1659 by 2212 pixels: 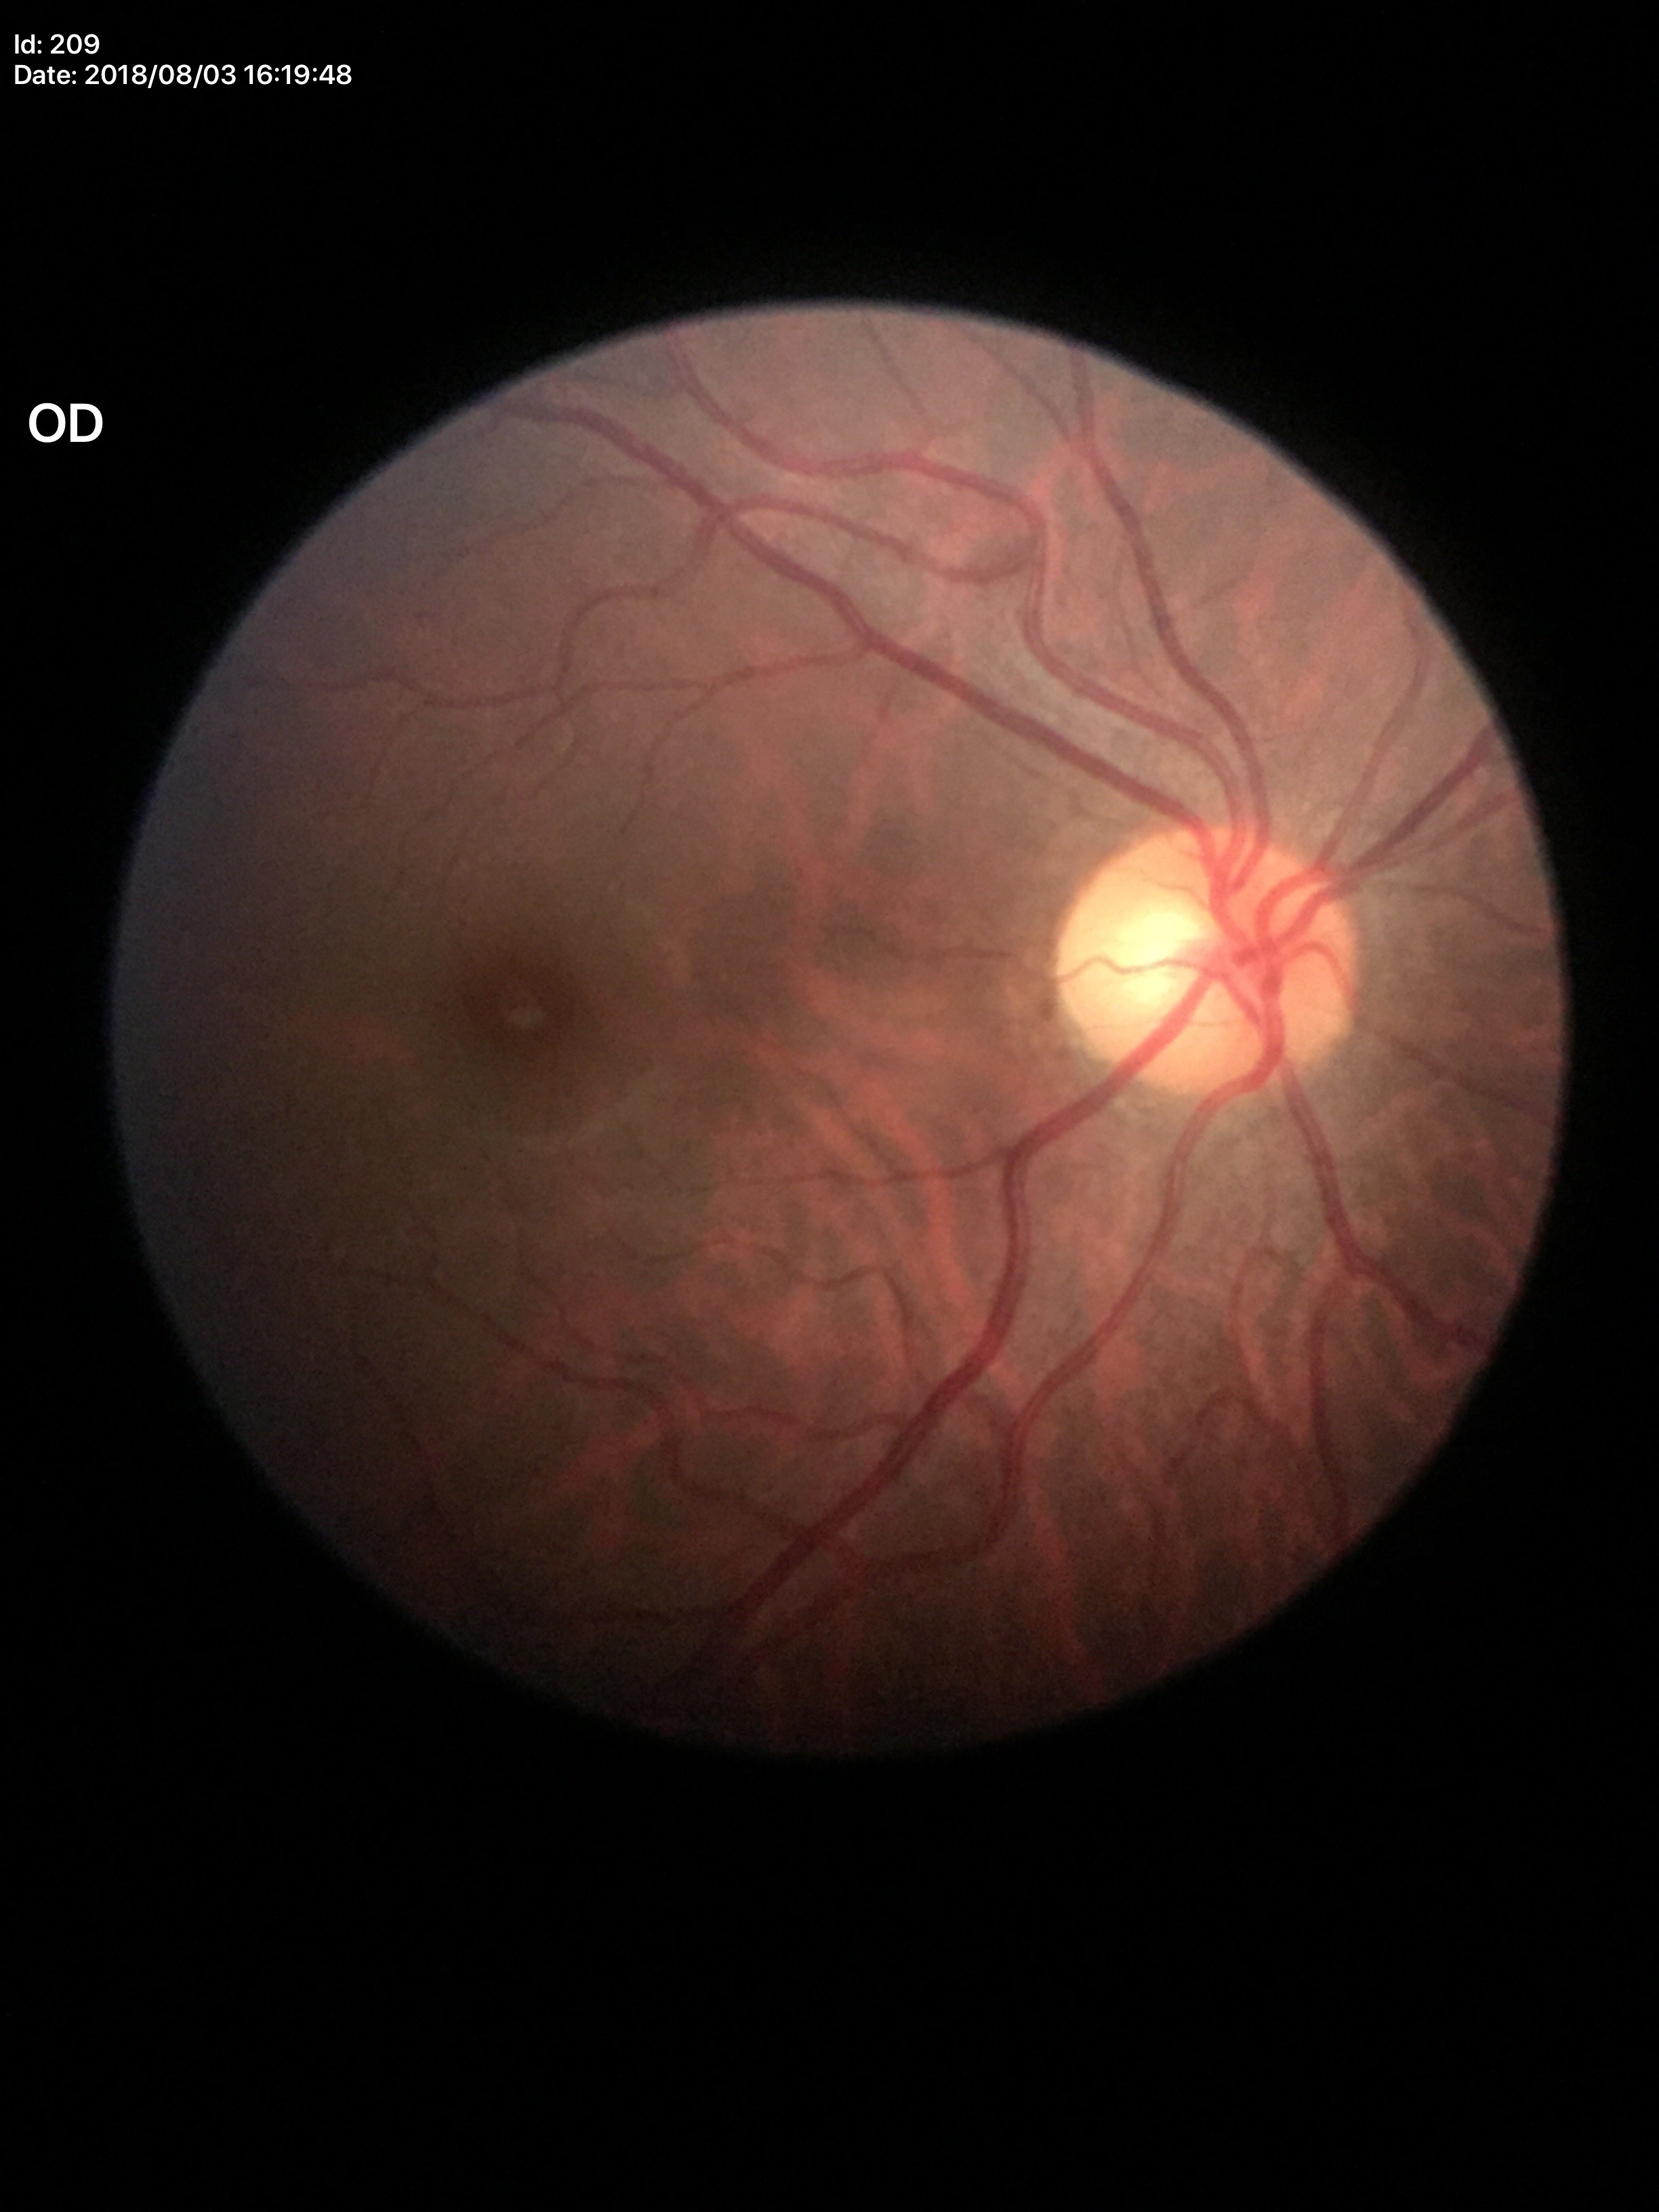

Vertical cup-disc ratio of 0.48. Glaucoma decision: no suspicious findings.